Sex: F. CFP. Corneal thickness: 551 µm. Age 80. Intraocular pressure 18 mmHg. 30° field of view
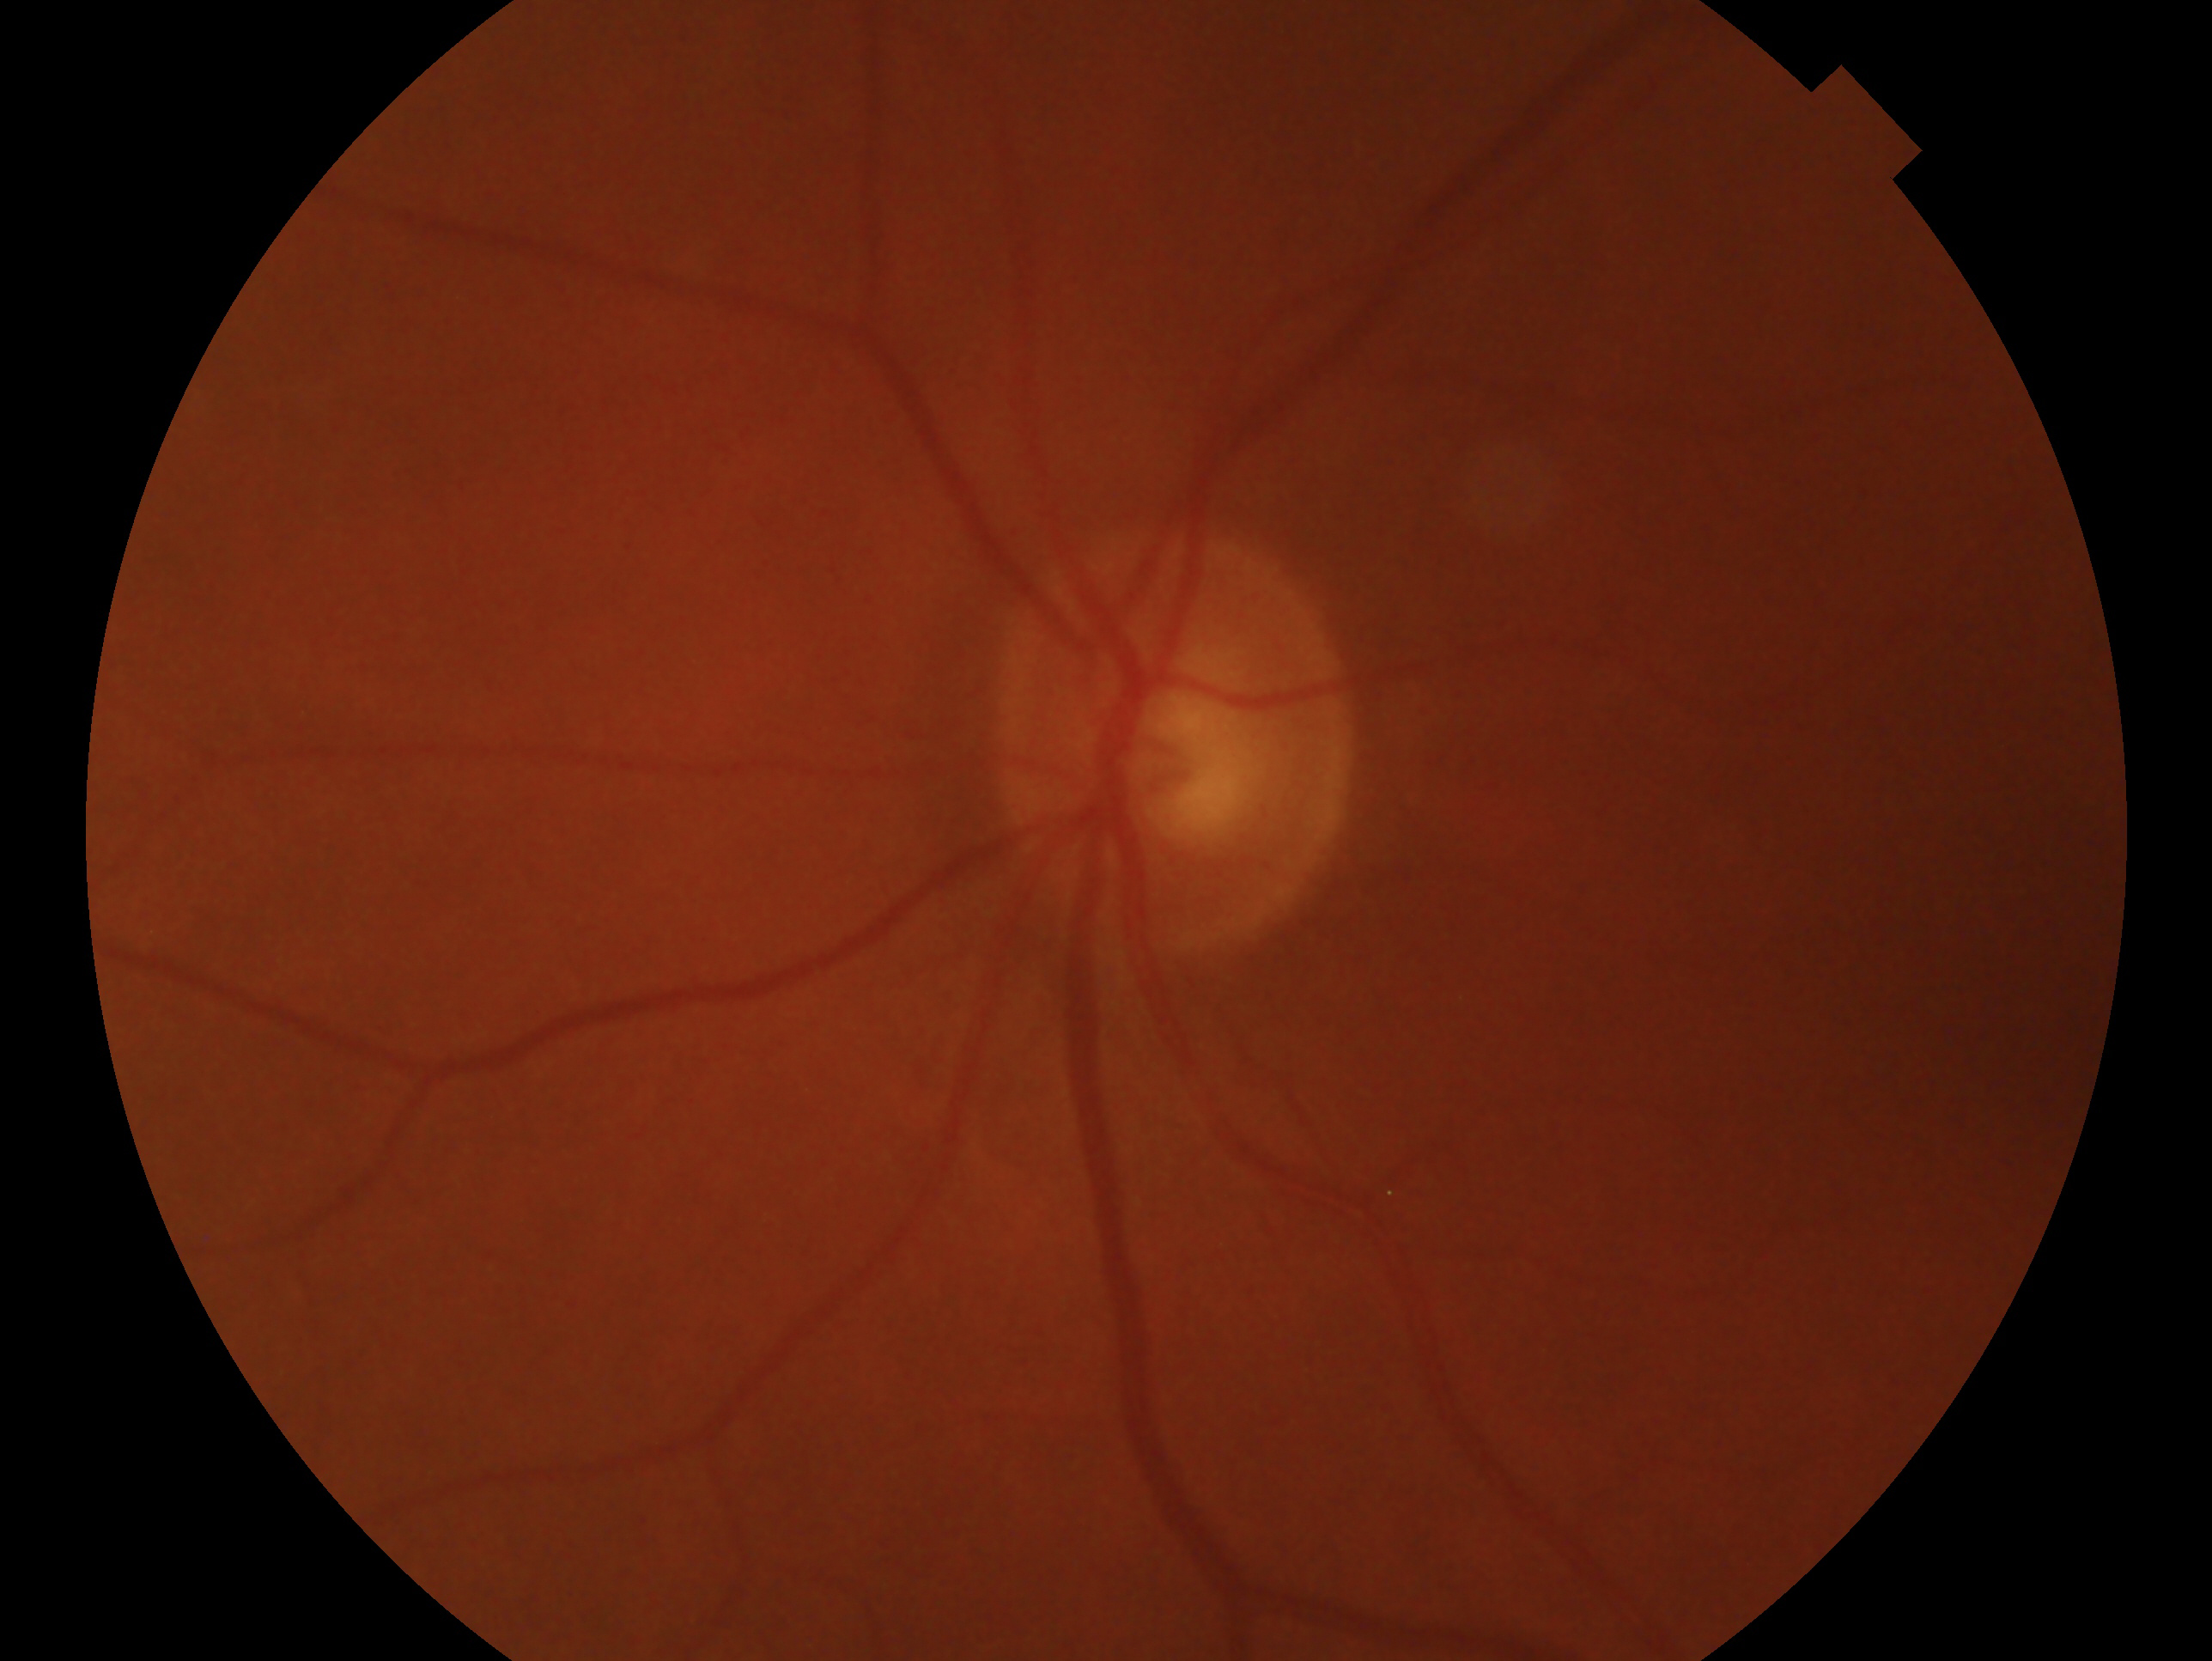

Clinical classification — possible glaucoma. Imaged eye: oculus sinister.